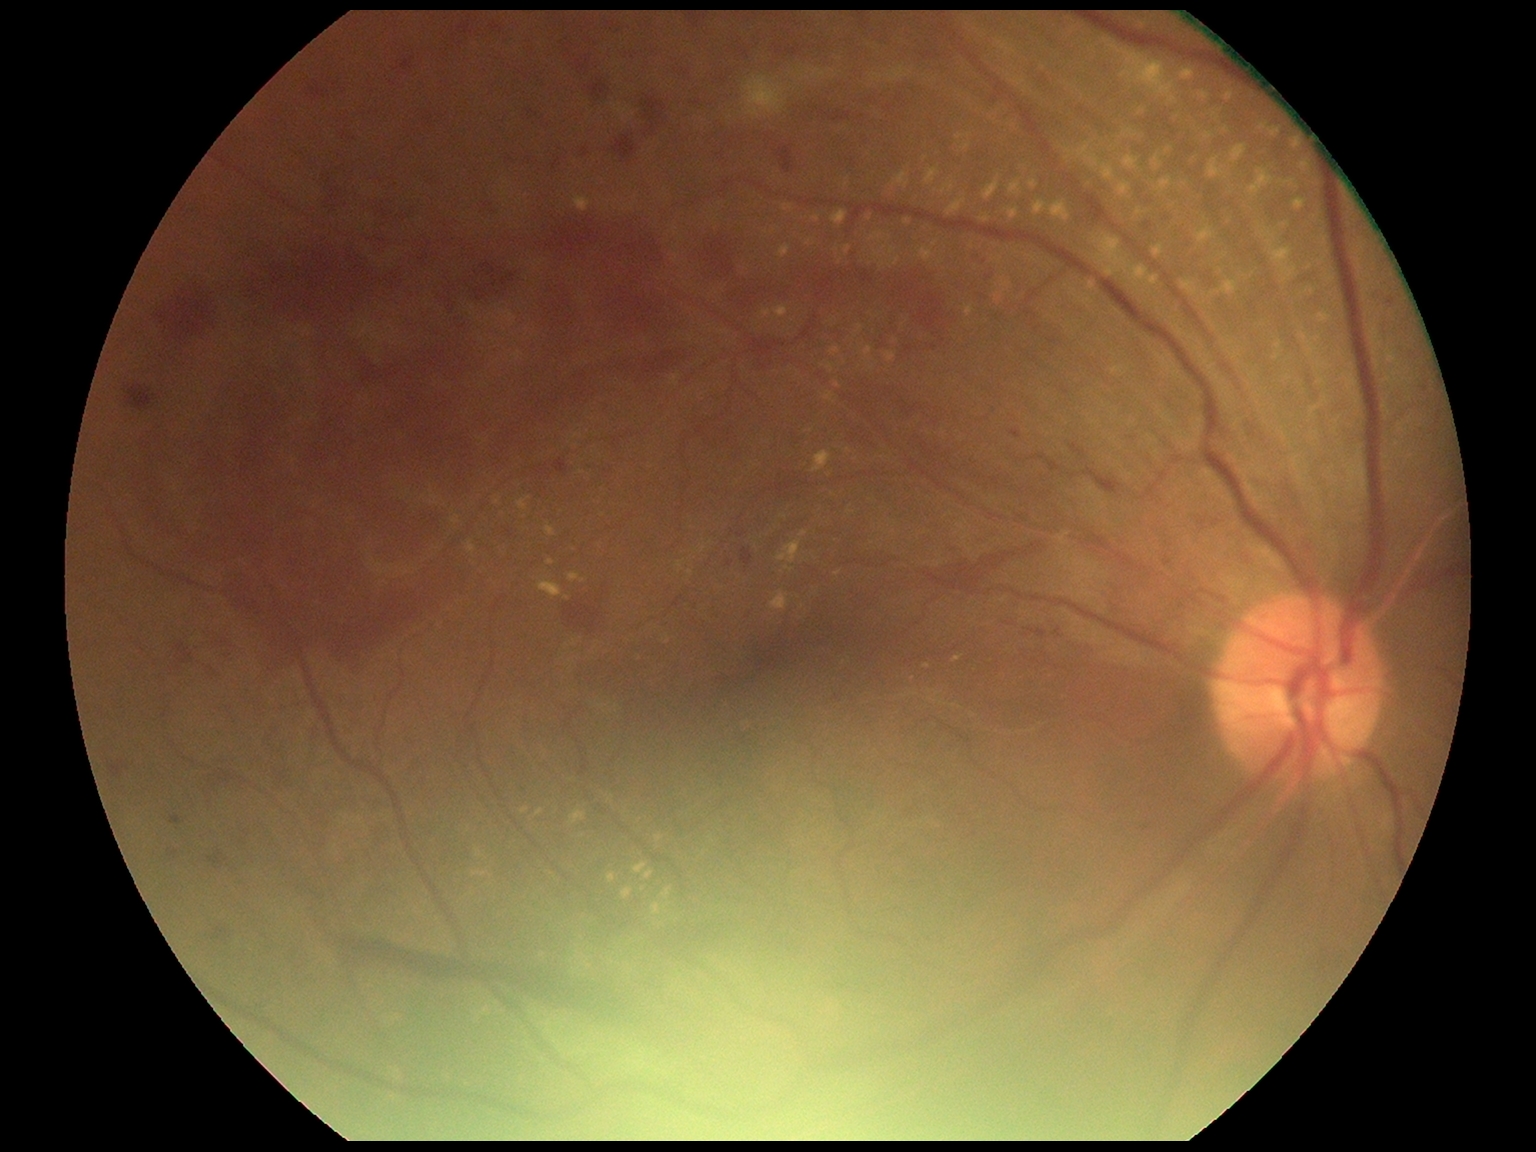 DR severity is PDR (grade 4) — neovascularization and/or vitreous/pre-retinal hemorrhage.